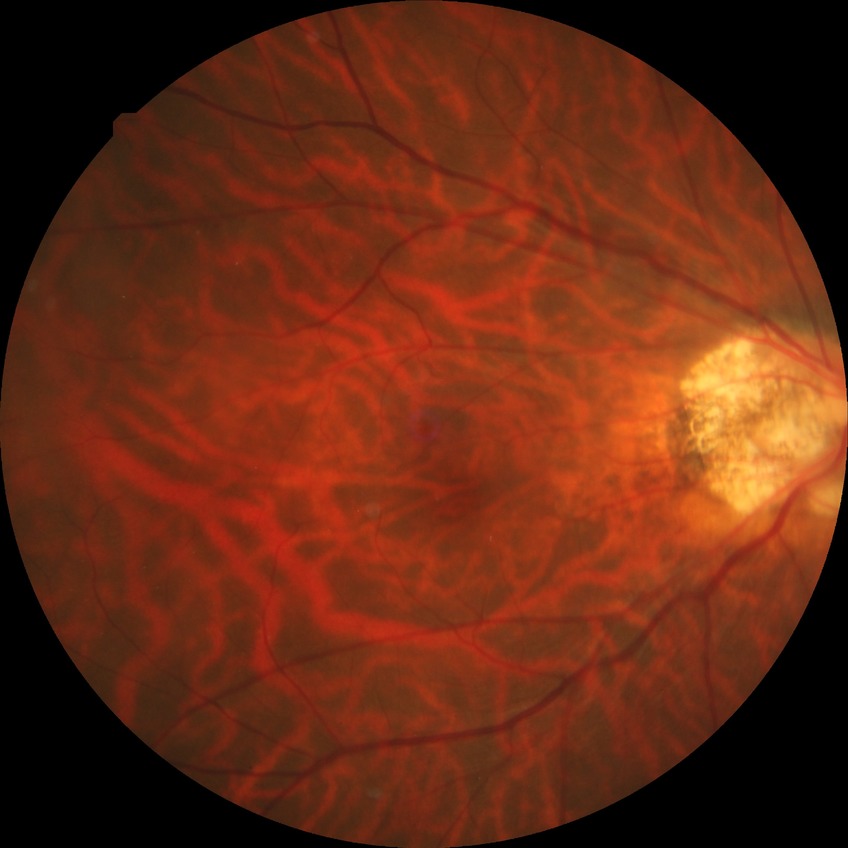
Diabetic retinopathy (DR) is NDR (no diabetic retinopathy).